50° field of view. Topcon TRC-50DX. Mydriatic (tropicamide and phenylephrine):
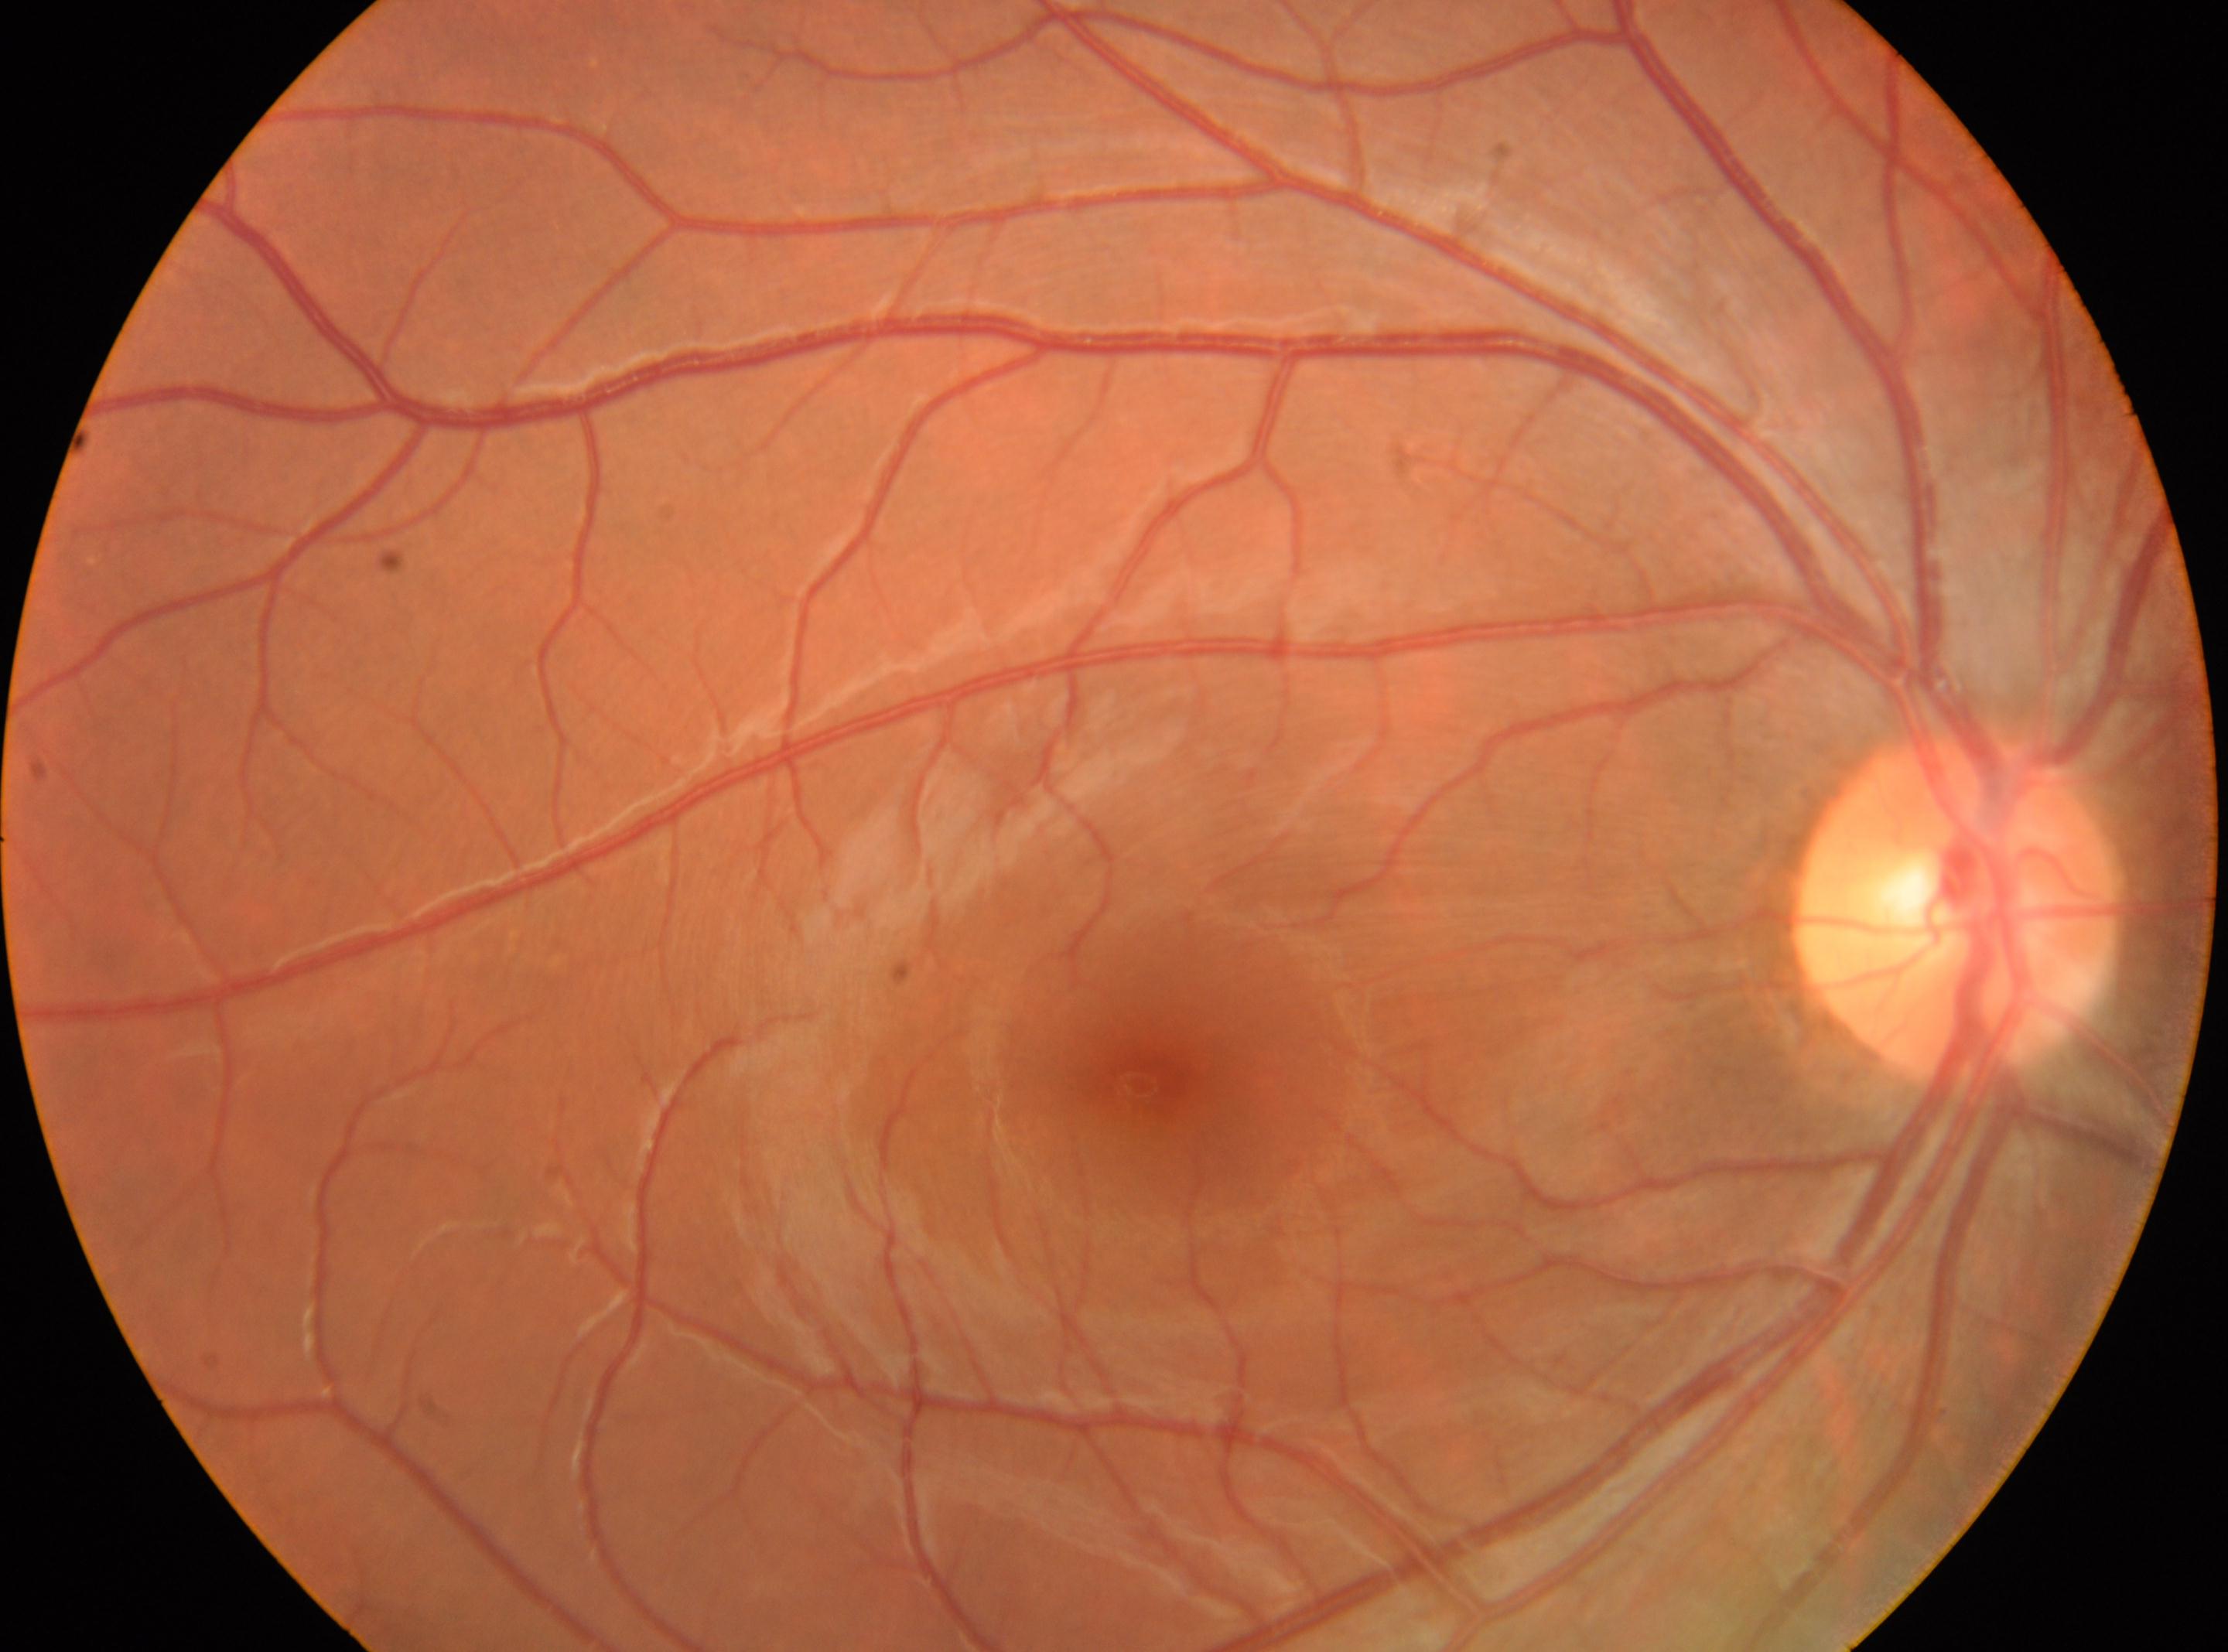
{
  "eye": "right",
  "optic_disc": "[1956, 902]",
  "fovea": "[1159, 1078]",
  "dr_grade": "0 (no apparent retinopathy)"
}